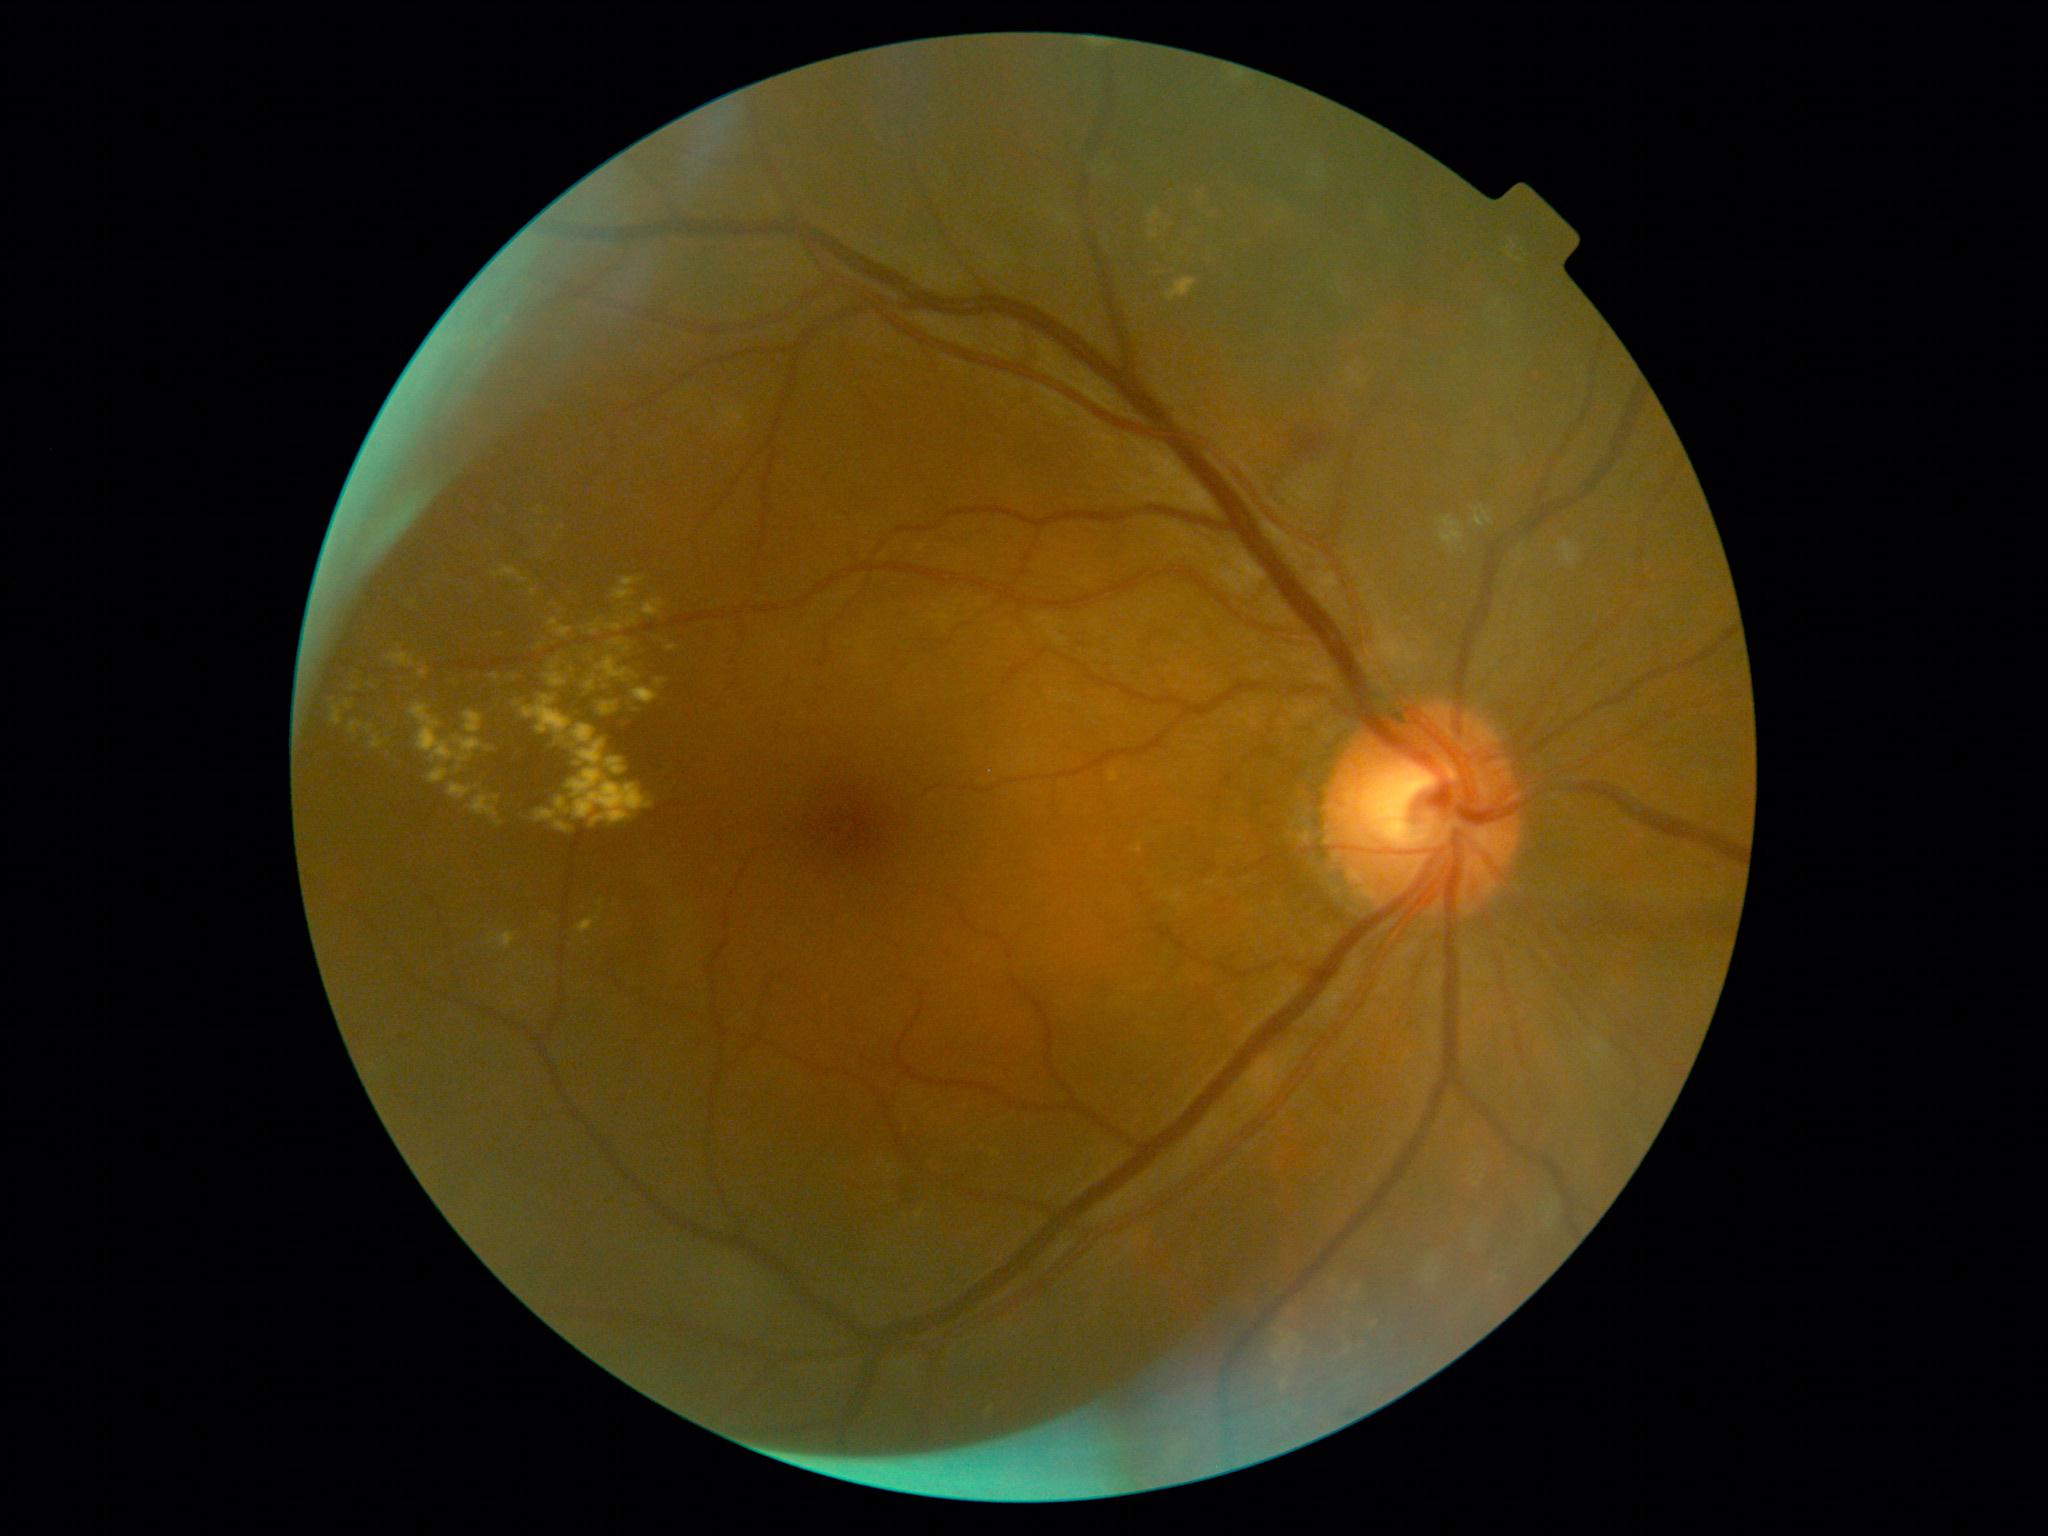 DR severity: grade 2. EXs (partial list) at x1=606, y1=624, x2=624, y2=632 | x1=655, y1=679, x2=668, y2=688 | x1=1152, y1=261, x2=1172, y2=274 | x1=641, y1=600, x2=664, y2=616 | x1=558, y1=642, x2=596, y2=670 | x1=387, y1=645, x2=417, y2=668 | x1=536, y1=507, x2=545, y2=514 | x1=365, y1=725, x2=374, y2=734 | x1=332, y1=708, x2=342, y2=726 | x1=573, y1=725, x2=595, y2=744 | x1=522, y1=695, x2=576, y2=754 | x1=1149, y1=228, x2=1159, y2=238 | x1=1149, y1=210, x2=1174, y2=234 | x1=632, y1=688, x2=660, y2=705. Additional small EXs near (414; 603) | (540; 525) | (518; 705).